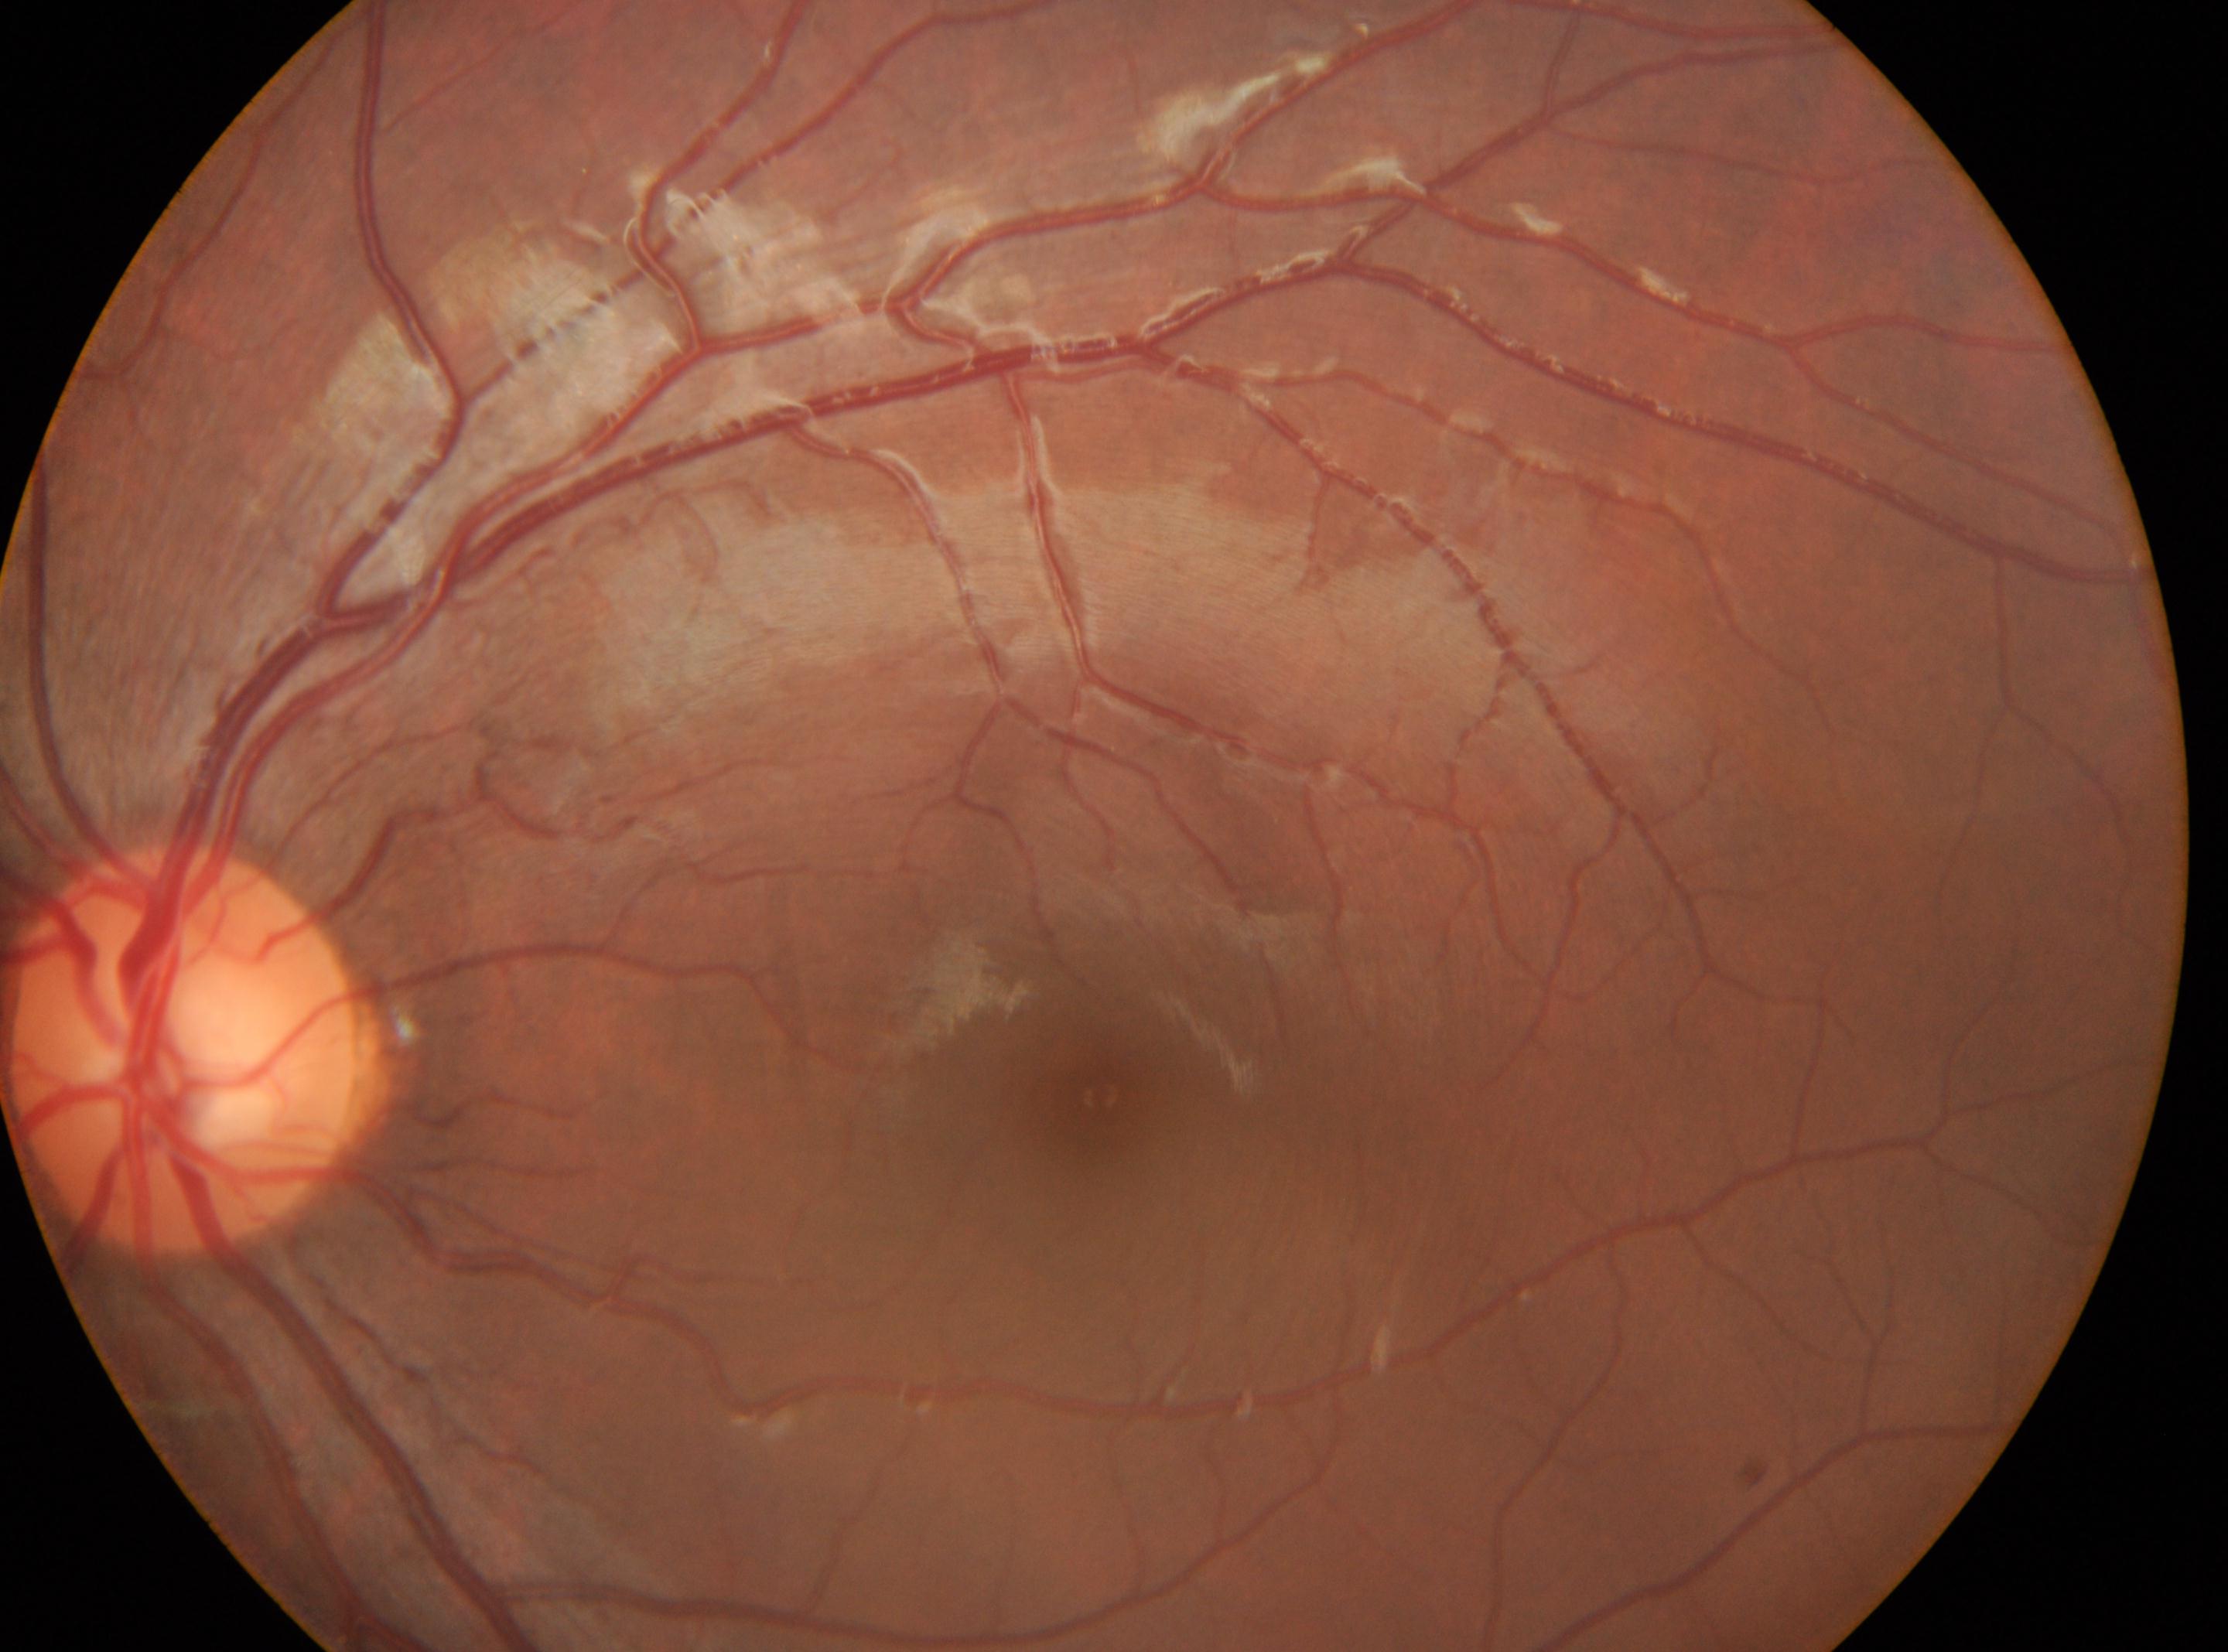
Disc center located at x=186, y=1050.
The fovea is at x=1097, y=1097.
DR is grade 0 — no visible signs of diabetic retinopathy.
Eye: oculus sinister.